Davis DR grading: 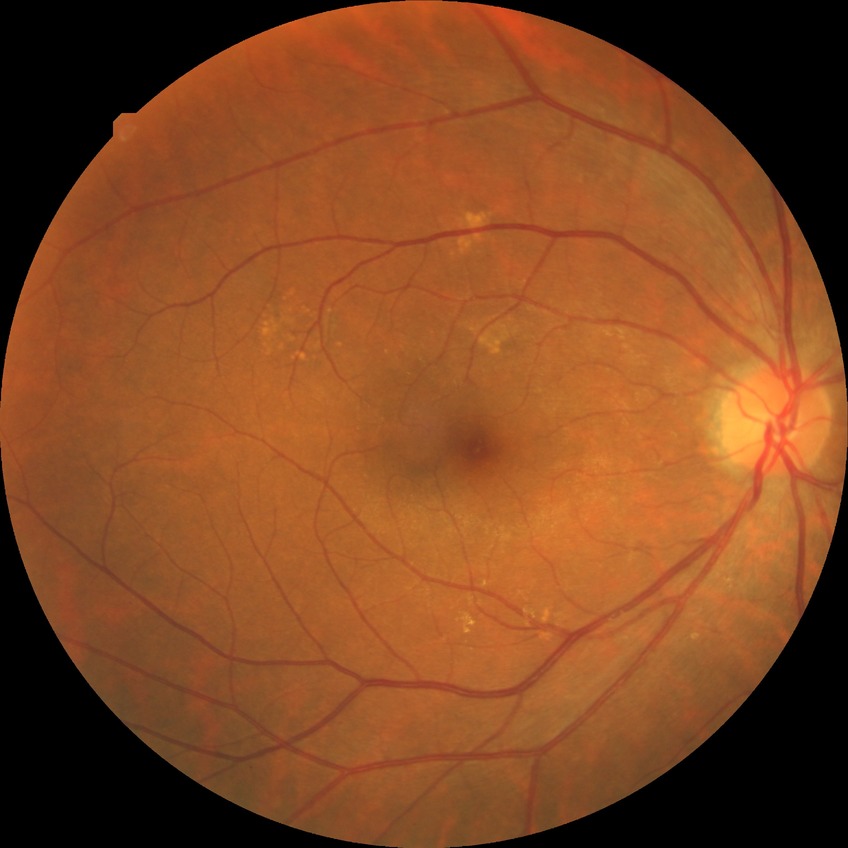 Diabetic retinopathy (DR): no diabetic retinopathy (NDR).